Wide-field contact fundus photograph of an infant; 1240x1240px.
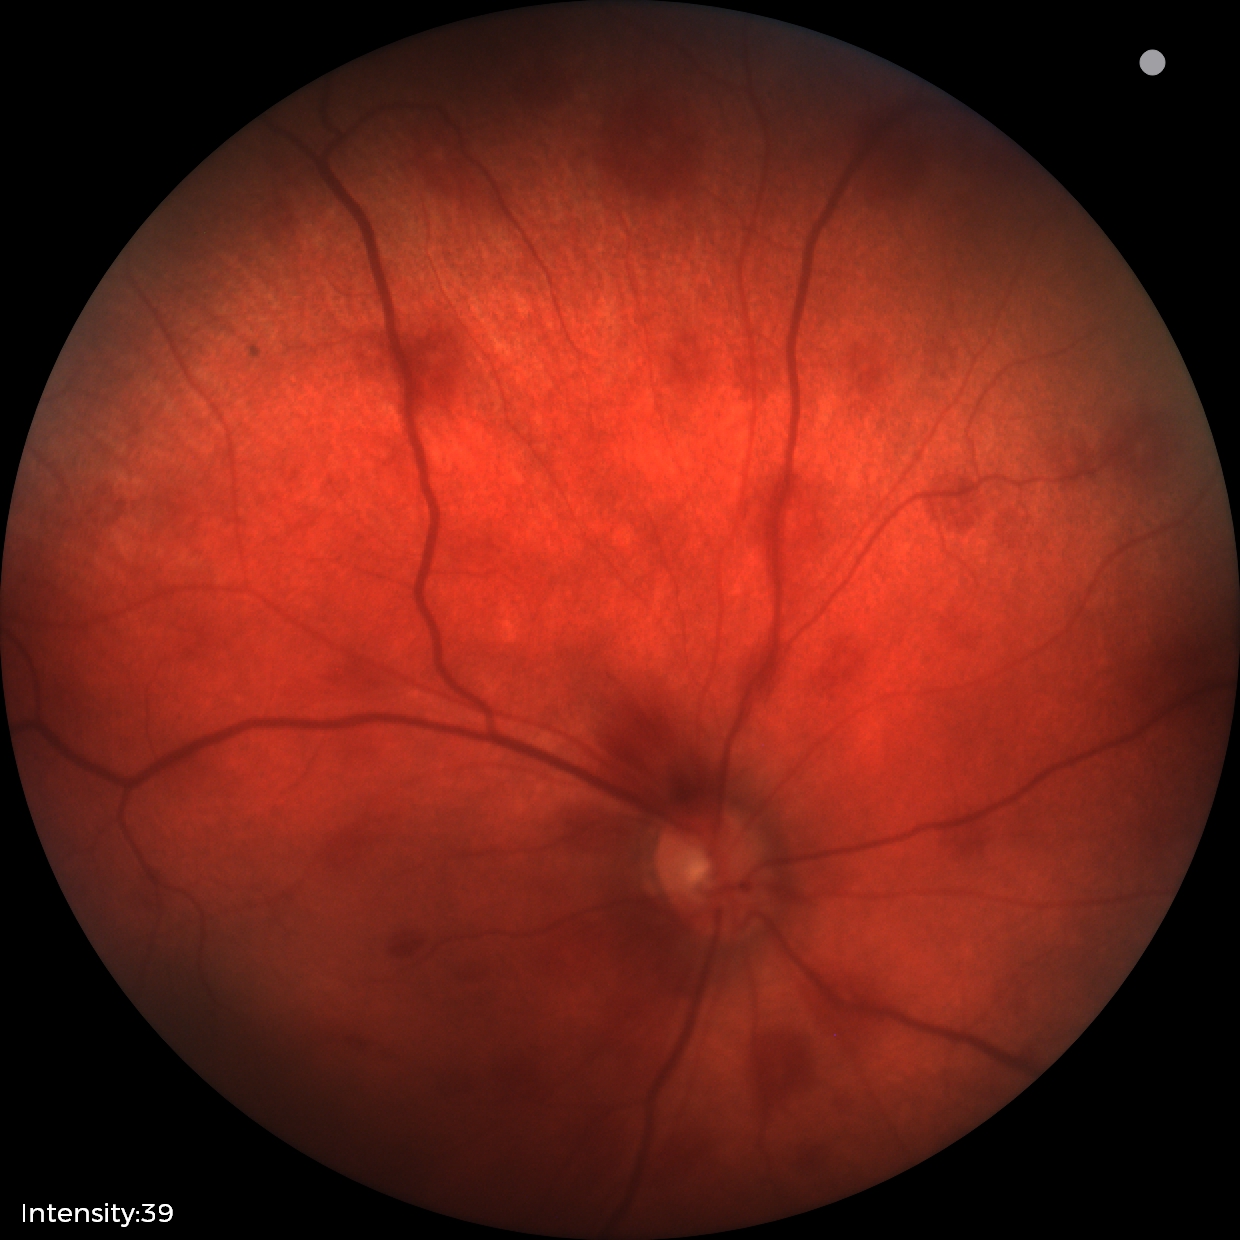 Screening examination consistent with retinal hemorrhages.